Acquired with a NIDEK AFC-230 · without pupil dilation · CFP · image size 848x848: 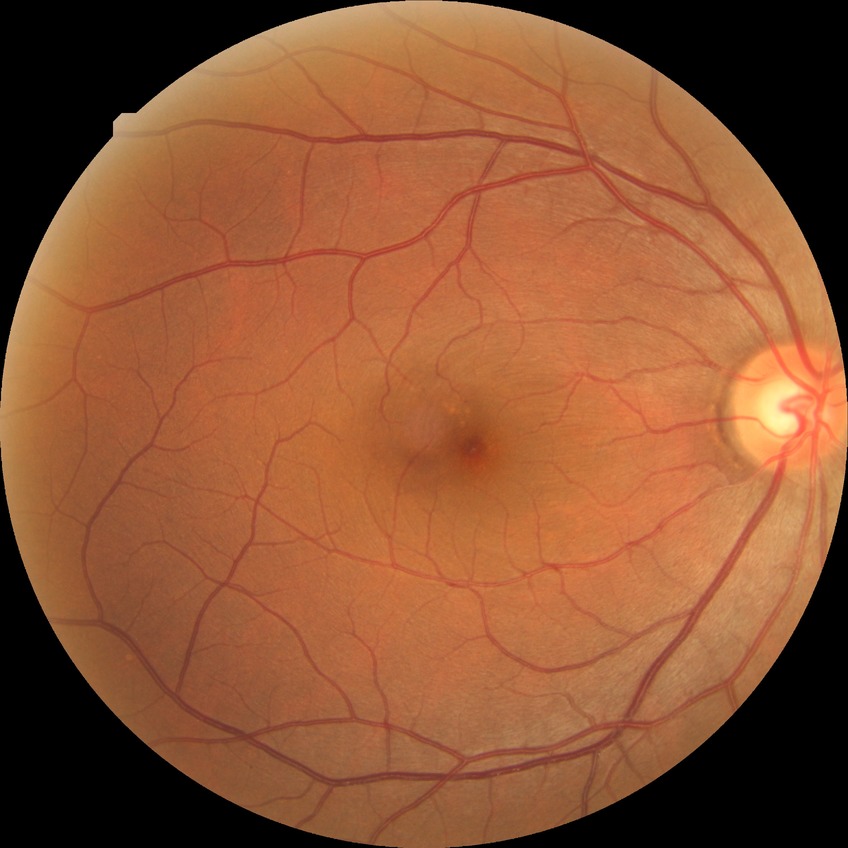 Diabetic retinopathy (DR): NDR (no diabetic retinopathy).